Modified Davis classification; camera: NIDEK AFC-230.
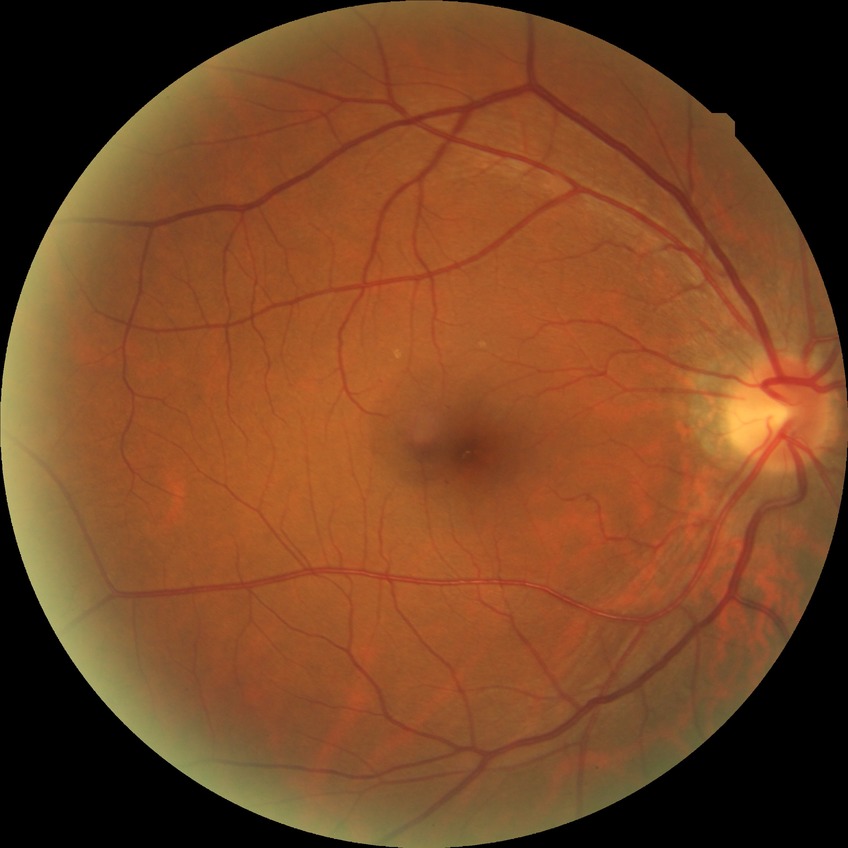 {"davis_grade": "NDR (no diabetic retinopathy)"}